Image size 2048x1536. 45° FOV
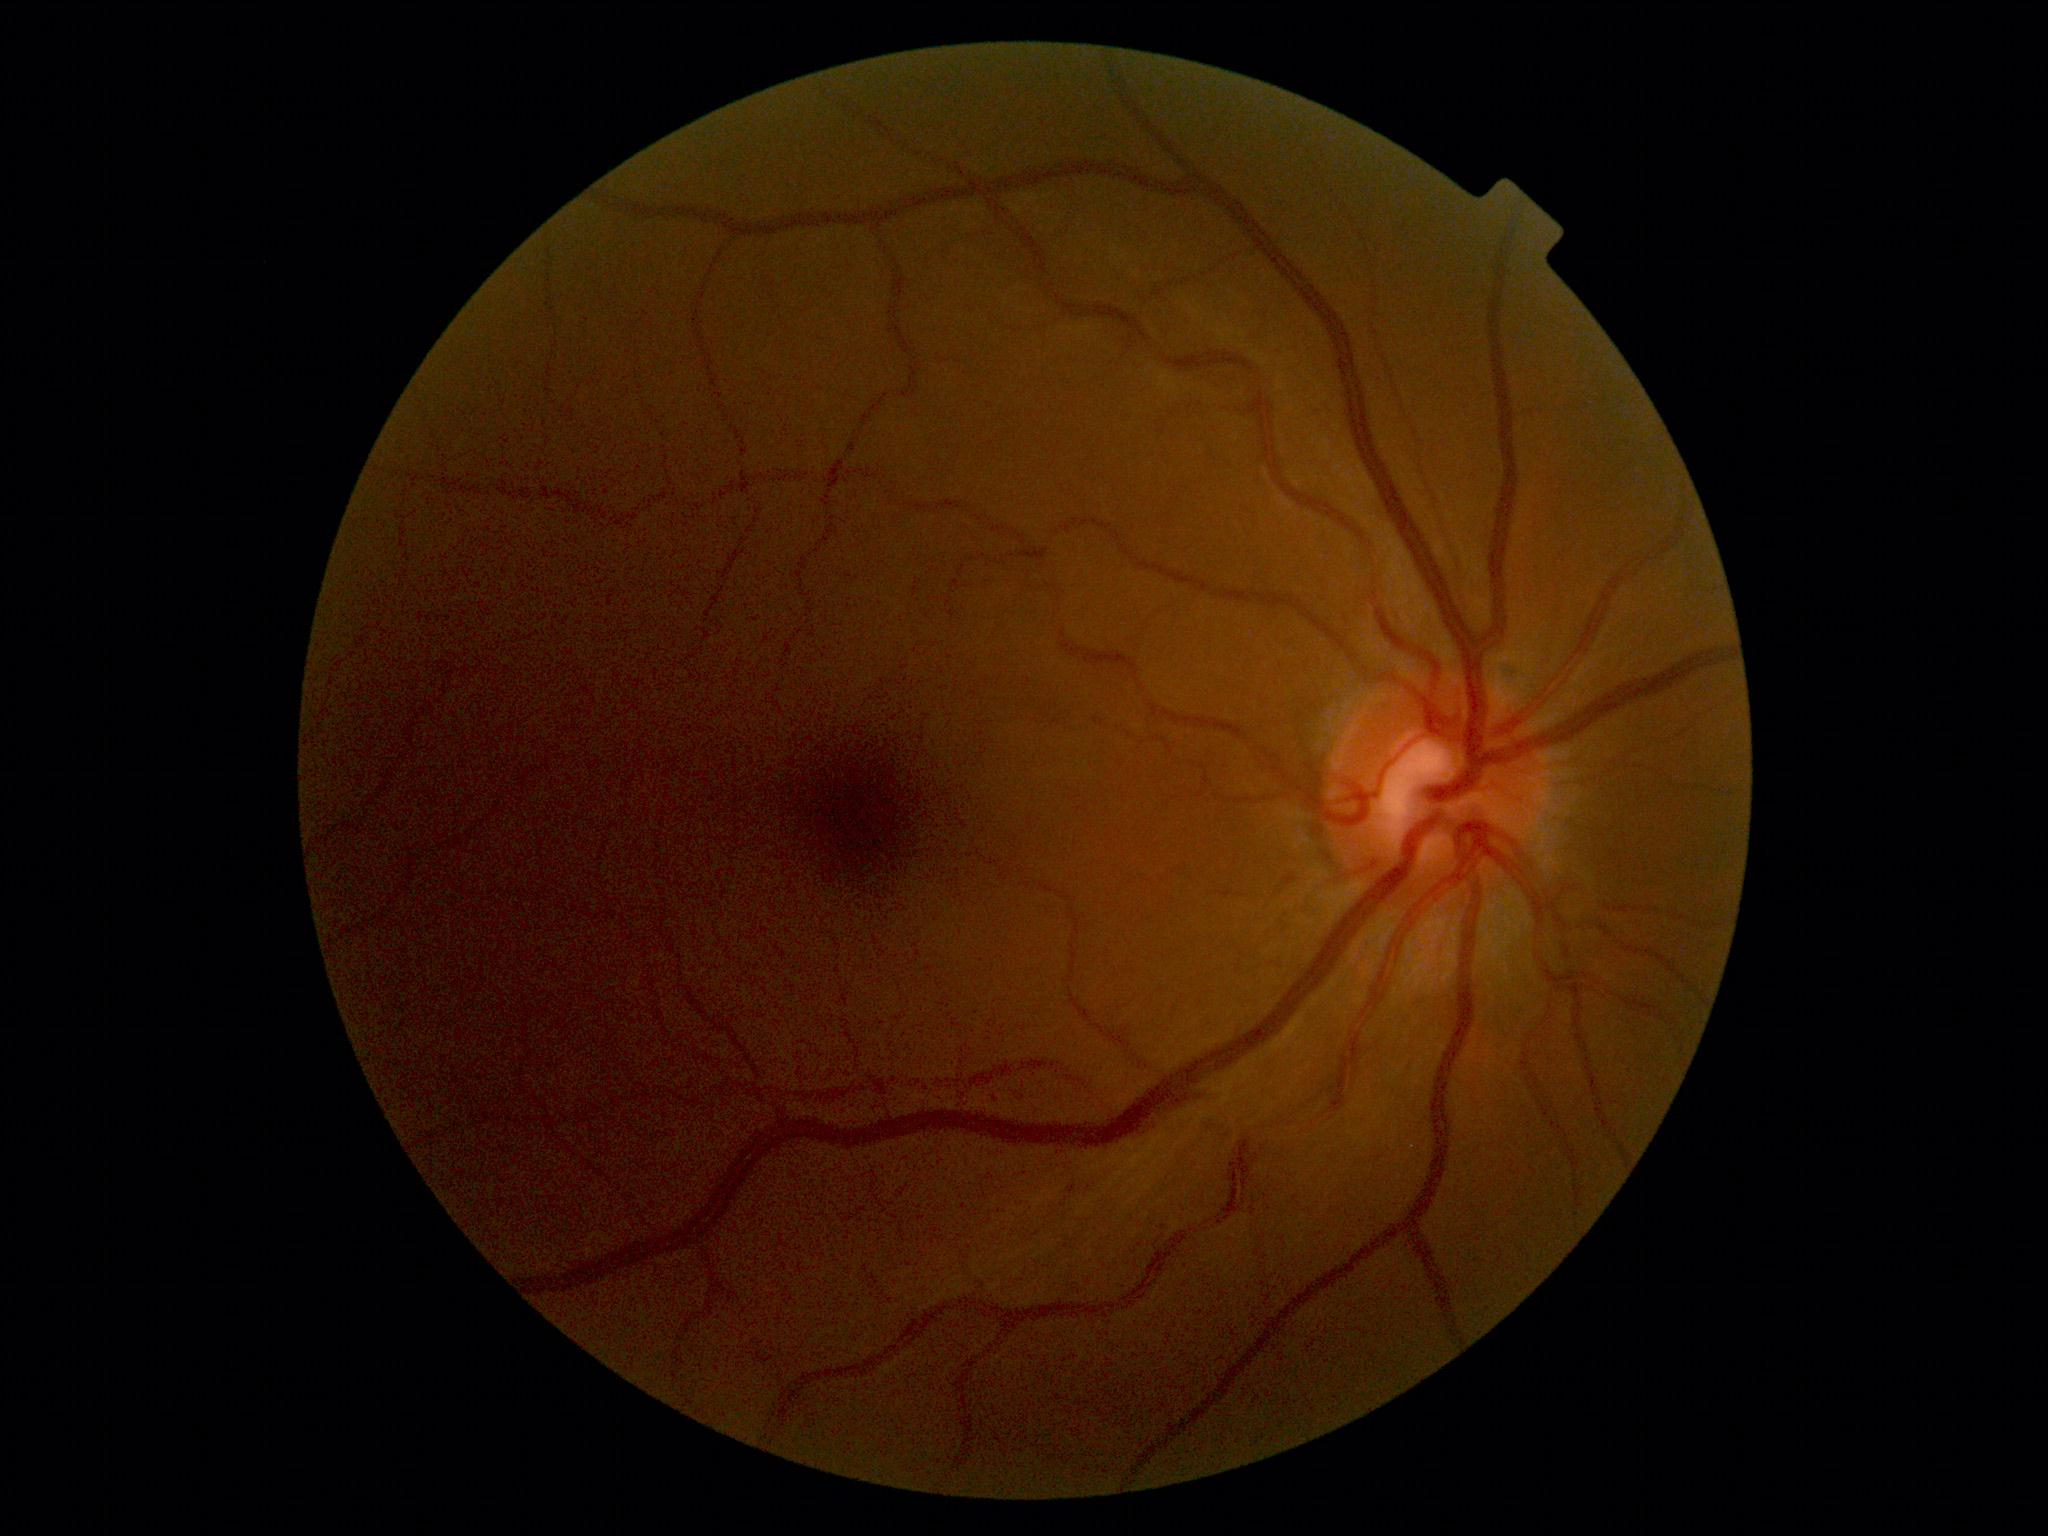
No DR findings.
DR: grade 0 (no apparent retinopathy).